Fundus photo. FOV: 45 degrees. 2352x1568:
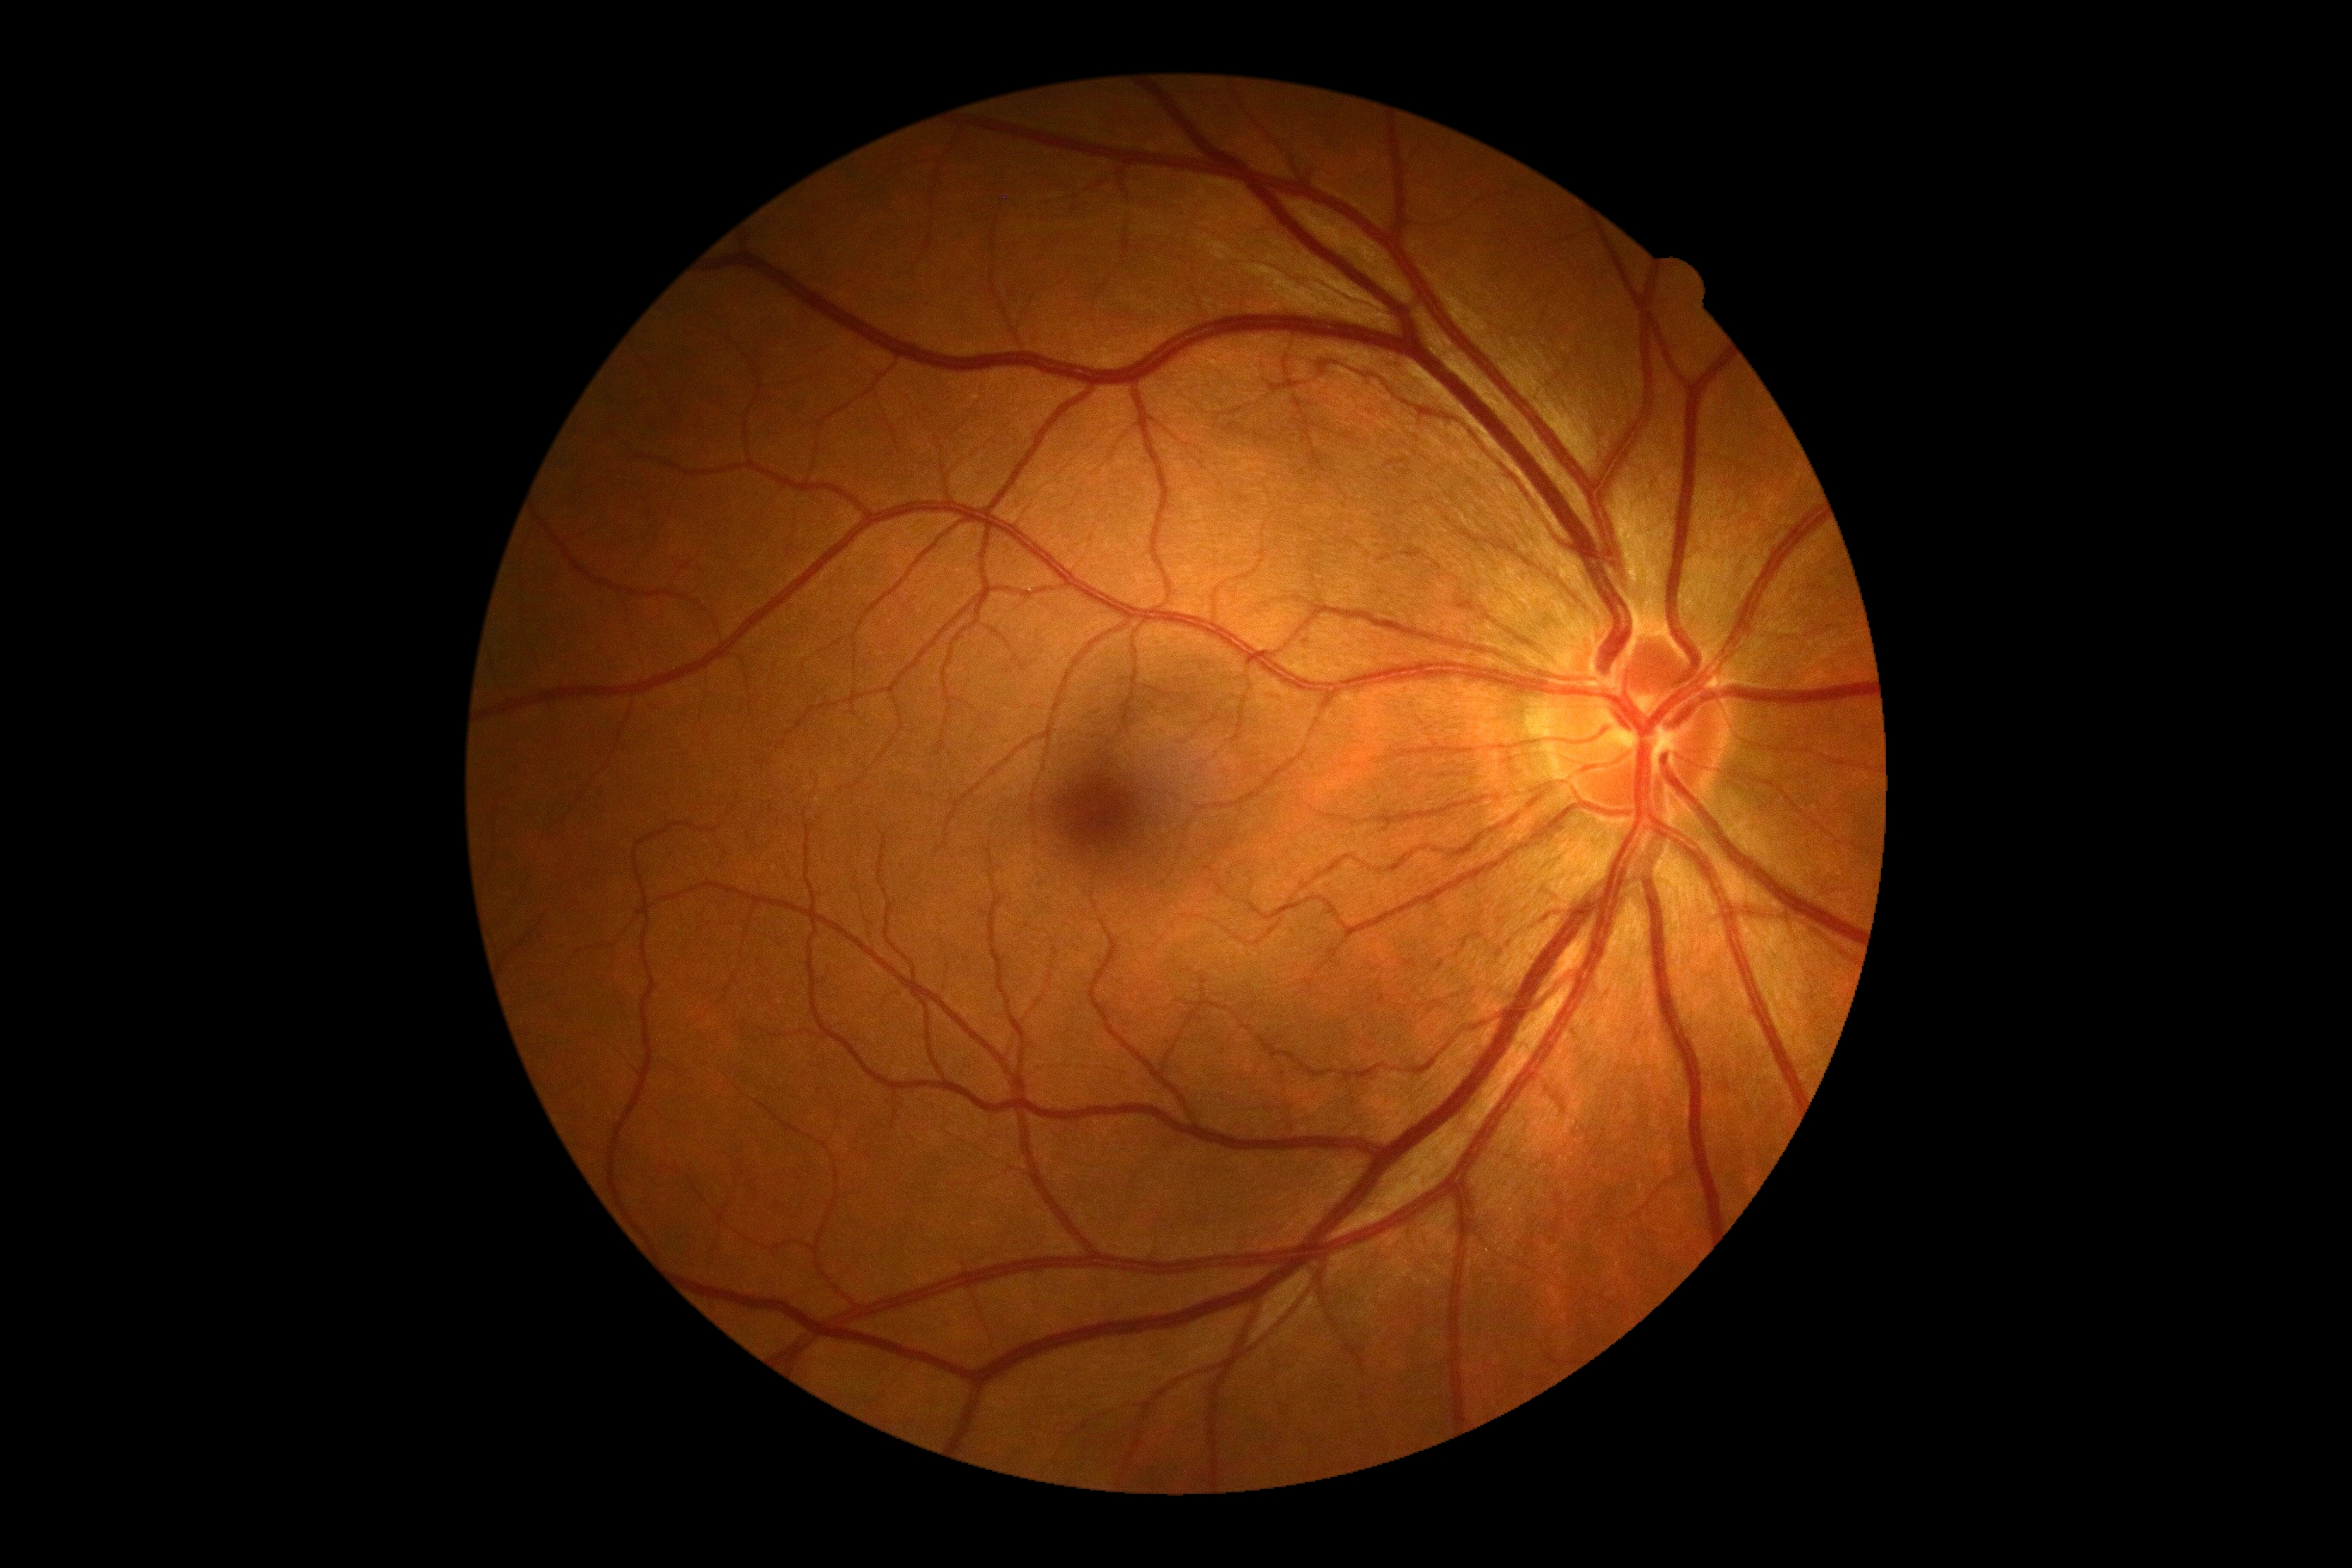 {
  "dr_grade": "0/4"
}